Nonmydriatic fundus photograph · FOV: 45 degrees · posterior pole color fundus photograph · 848x848 · NIDEK AFC-230
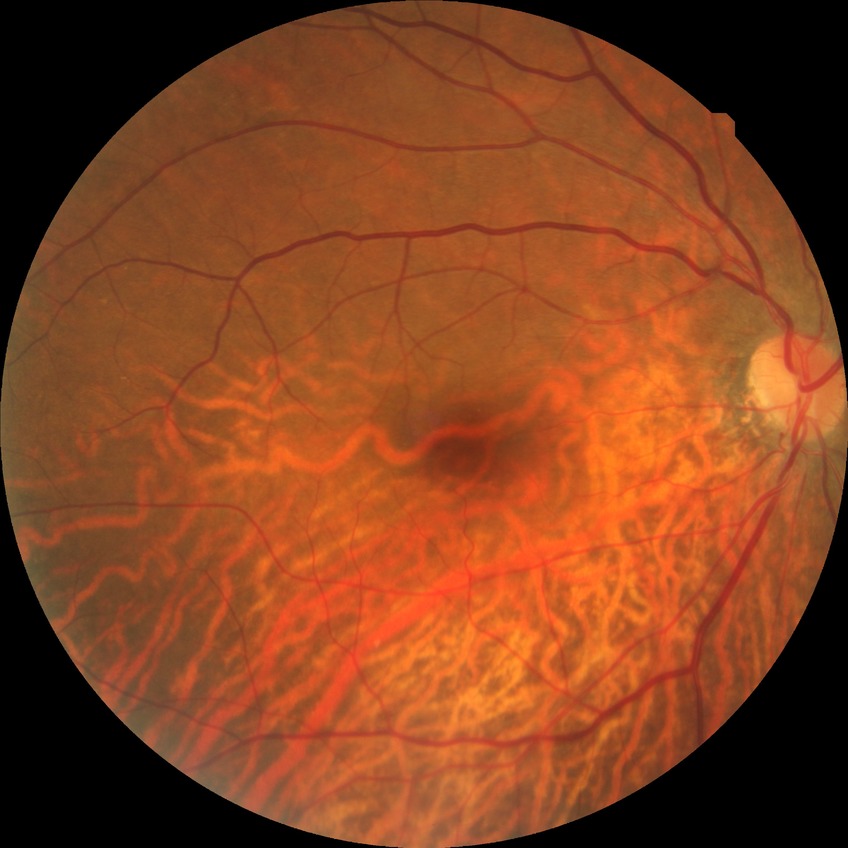

{"davis_grade": "no diabetic retinopathy"}